Pupil-dilated, 2228 x 1652 pixels
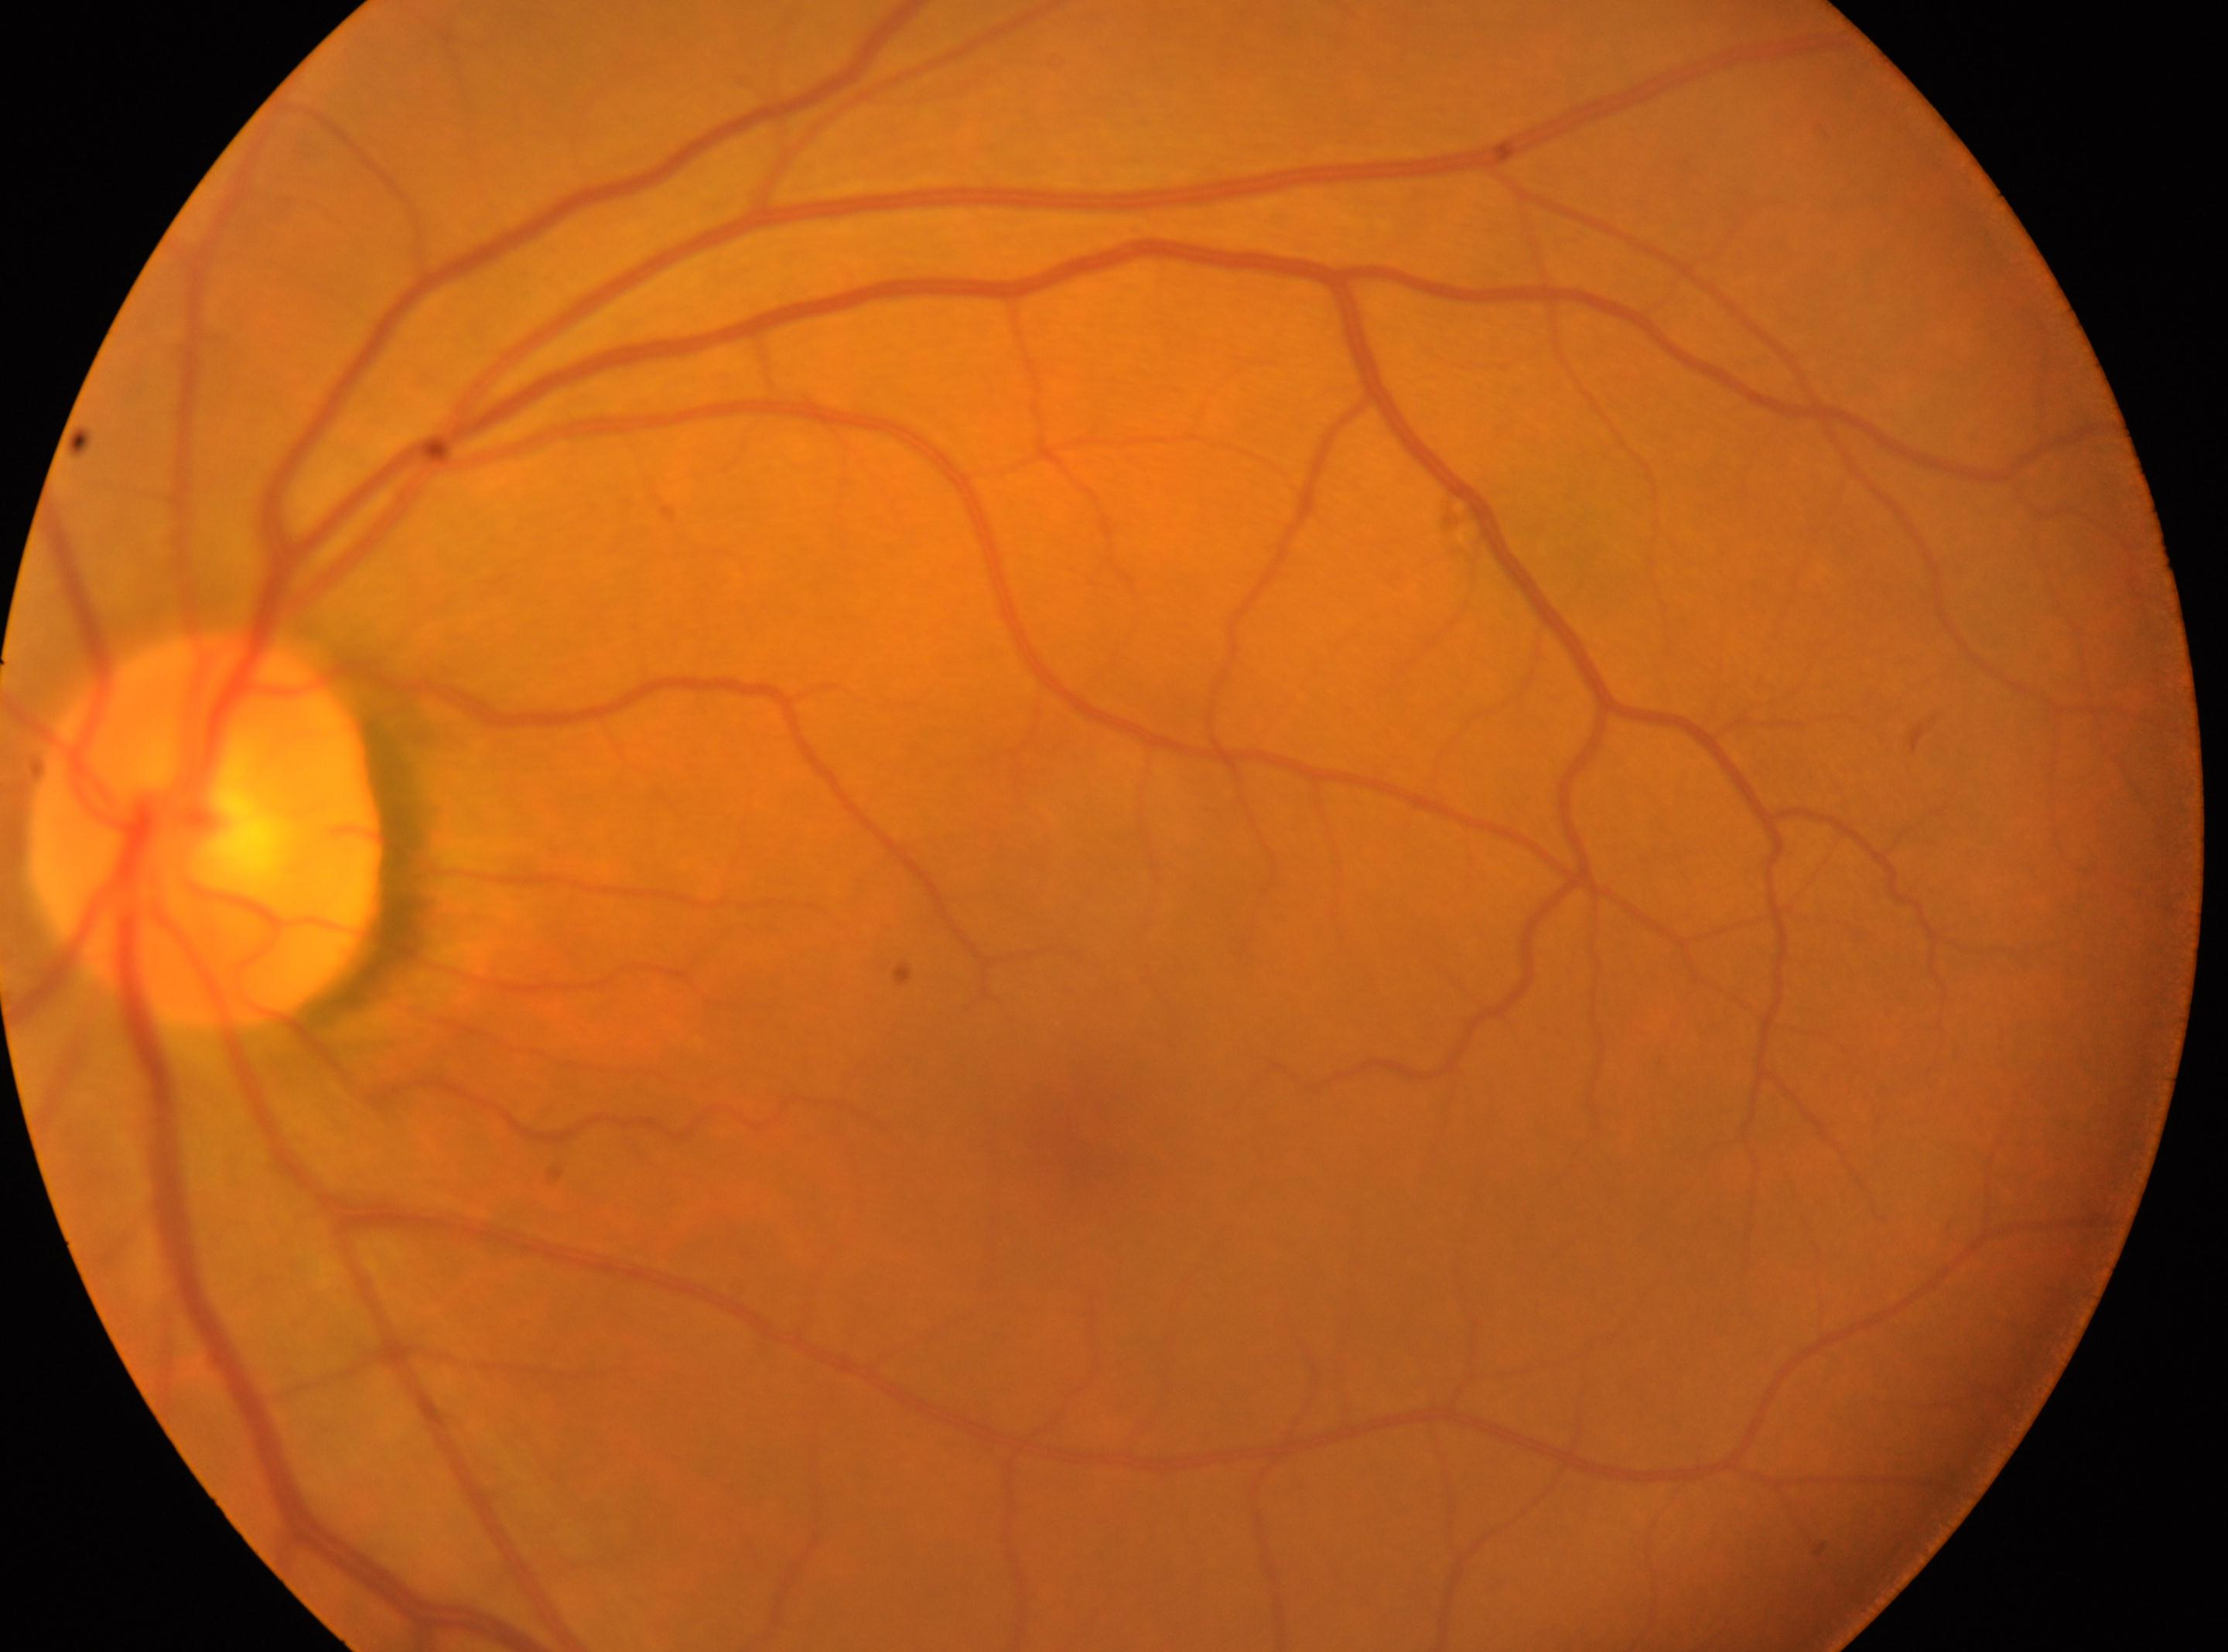 DR impression: No diabetic retinopathy identified | DR severity: no apparent retinopathy (grade 0) | laterality: oculus sinister | optic disk: [207, 832] | fovea: [1088, 1142].